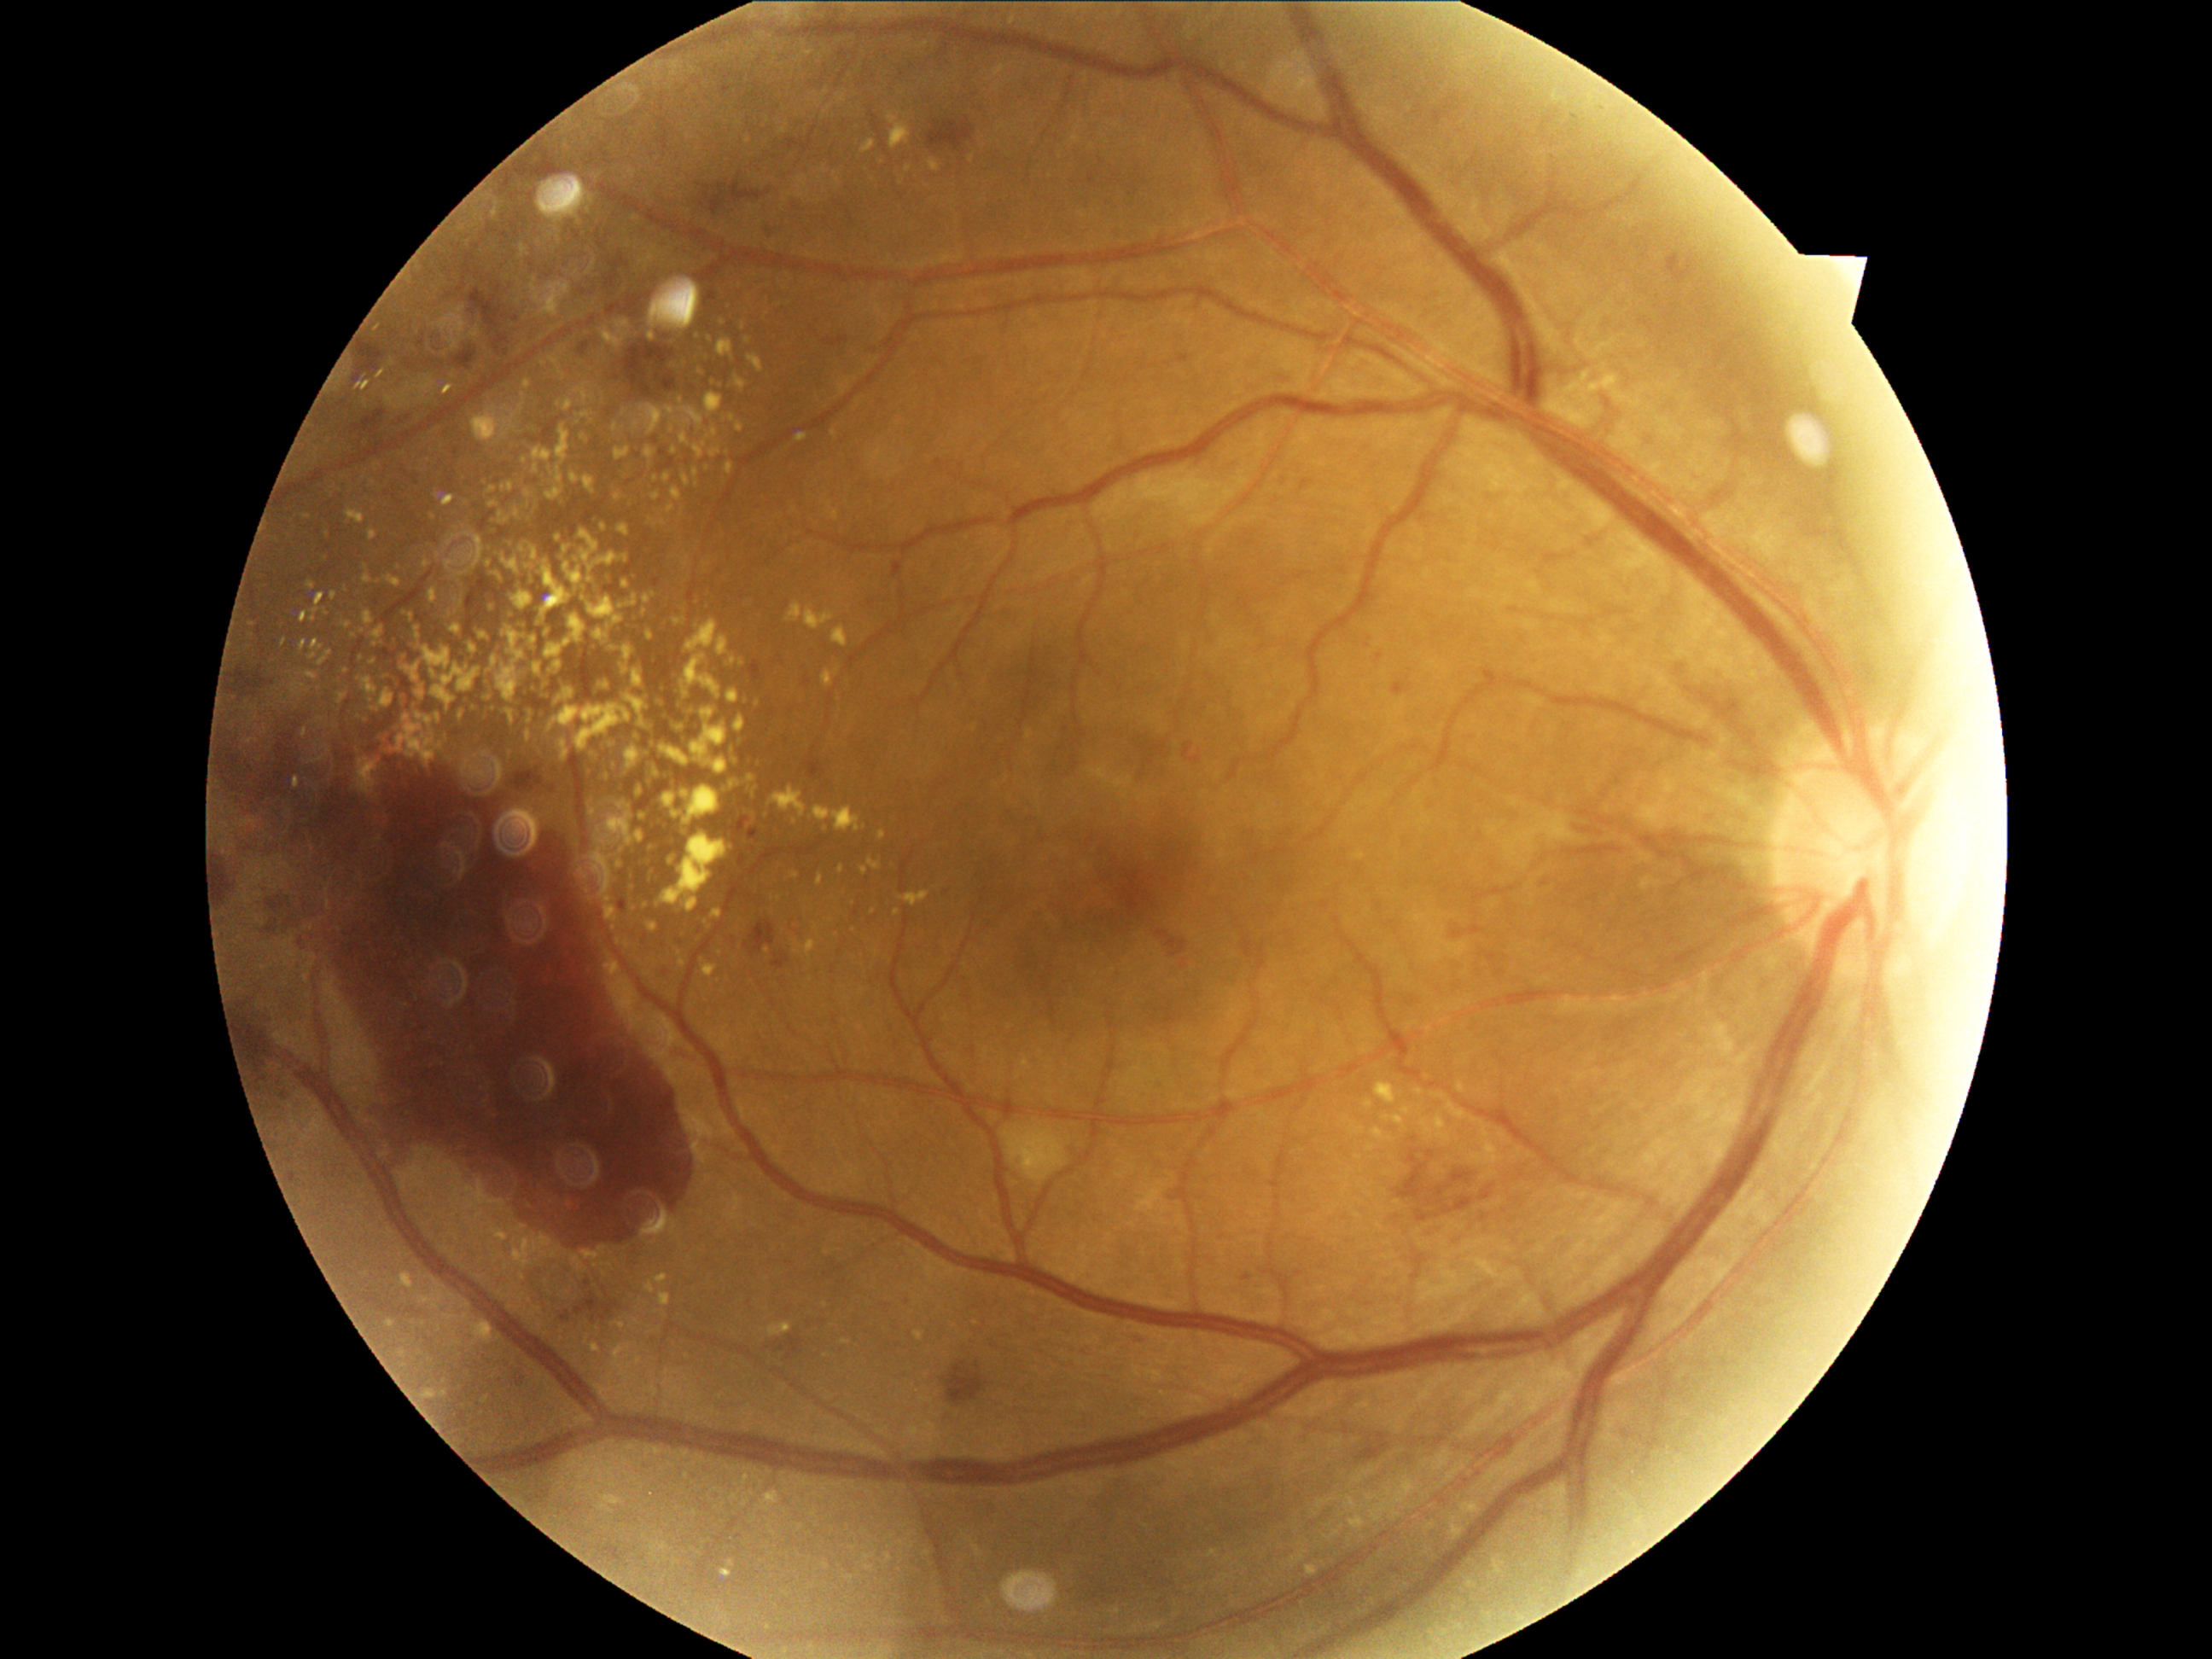

Diabetic retinopathy severity: grade 4 (PDR)
Selected lesions:
hard exudates (more not shown) = bbox=[532, 637, 537, 646] | bbox=[1494, 1559, 1505, 1573] | bbox=[1458, 1085, 1465, 1093] | bbox=[431, 665, 480, 711] | bbox=[602, 1496, 624, 1506] | bbox=[832, 627, 849, 648] | bbox=[579, 870, 586, 880] | bbox=[518, 1225, 527, 1231] | bbox=[465, 537, 484, 568] | bbox=[673, 489, 682, 501] | bbox=[356, 655, 364, 663] | bbox=[764, 1493, 777, 1505]
Smaller hard exudates around (364, 717) | (468, 535) | (525, 460) | (541, 716) | (687, 366) | (646, 753) | (462, 716)